Phoenix ICON, 100° FOV. Image size 1240x1240. Wide-field fundus photograph from neonatal ROP screening — 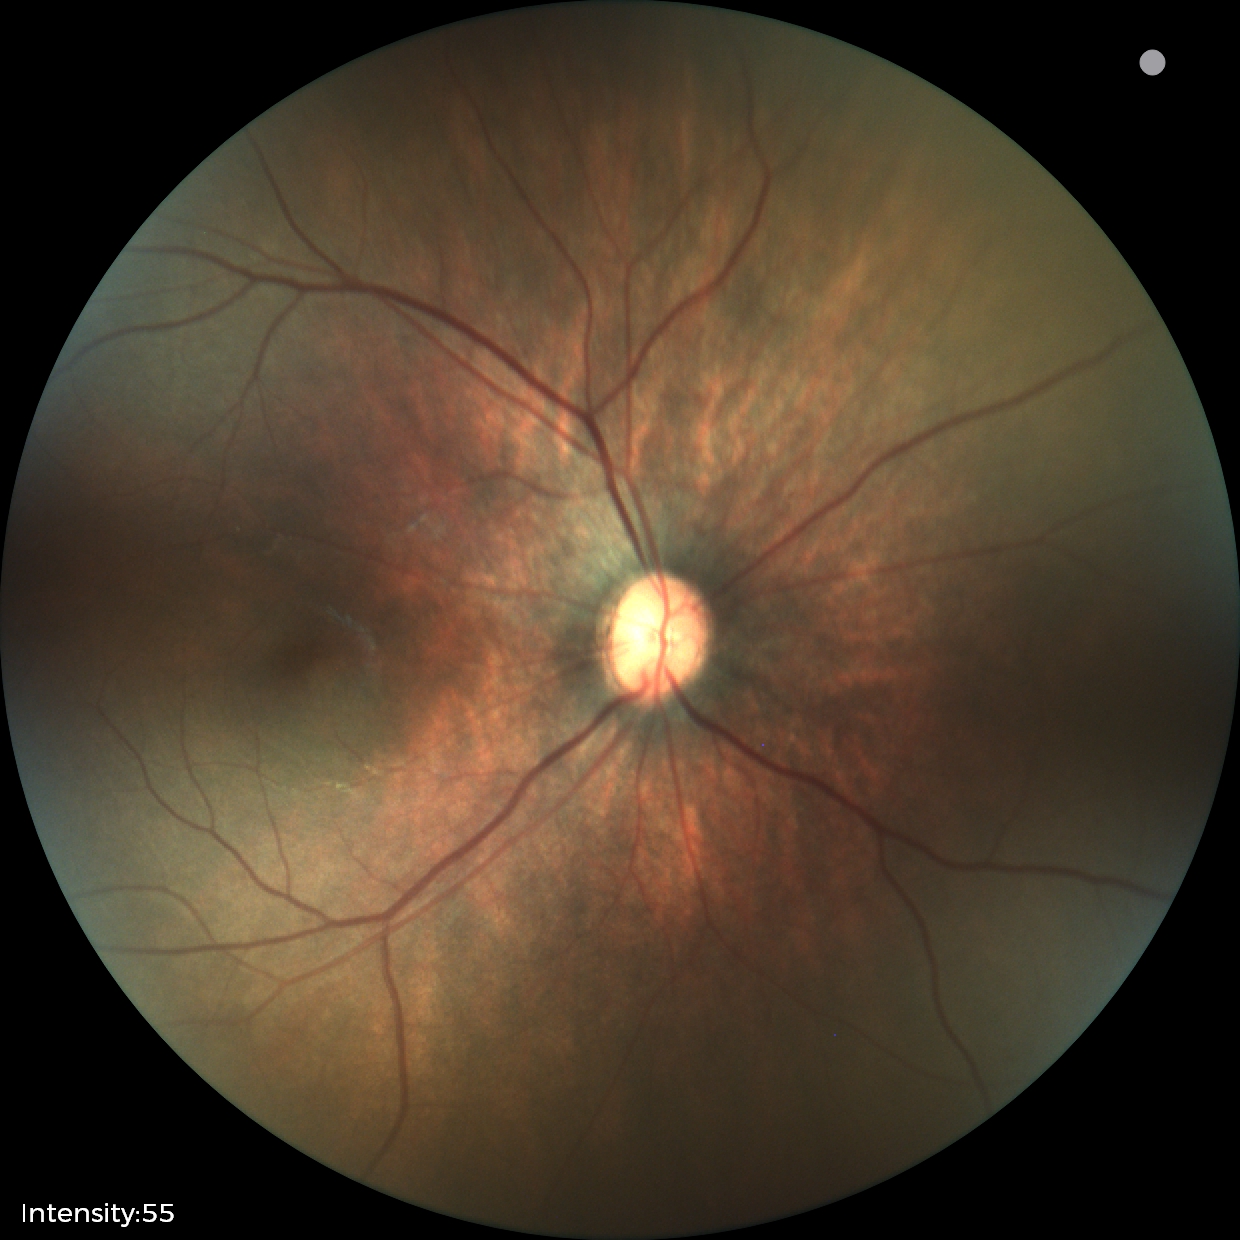 No retinal pathology identified on screening.